50-degree field of view, posterior pole view.
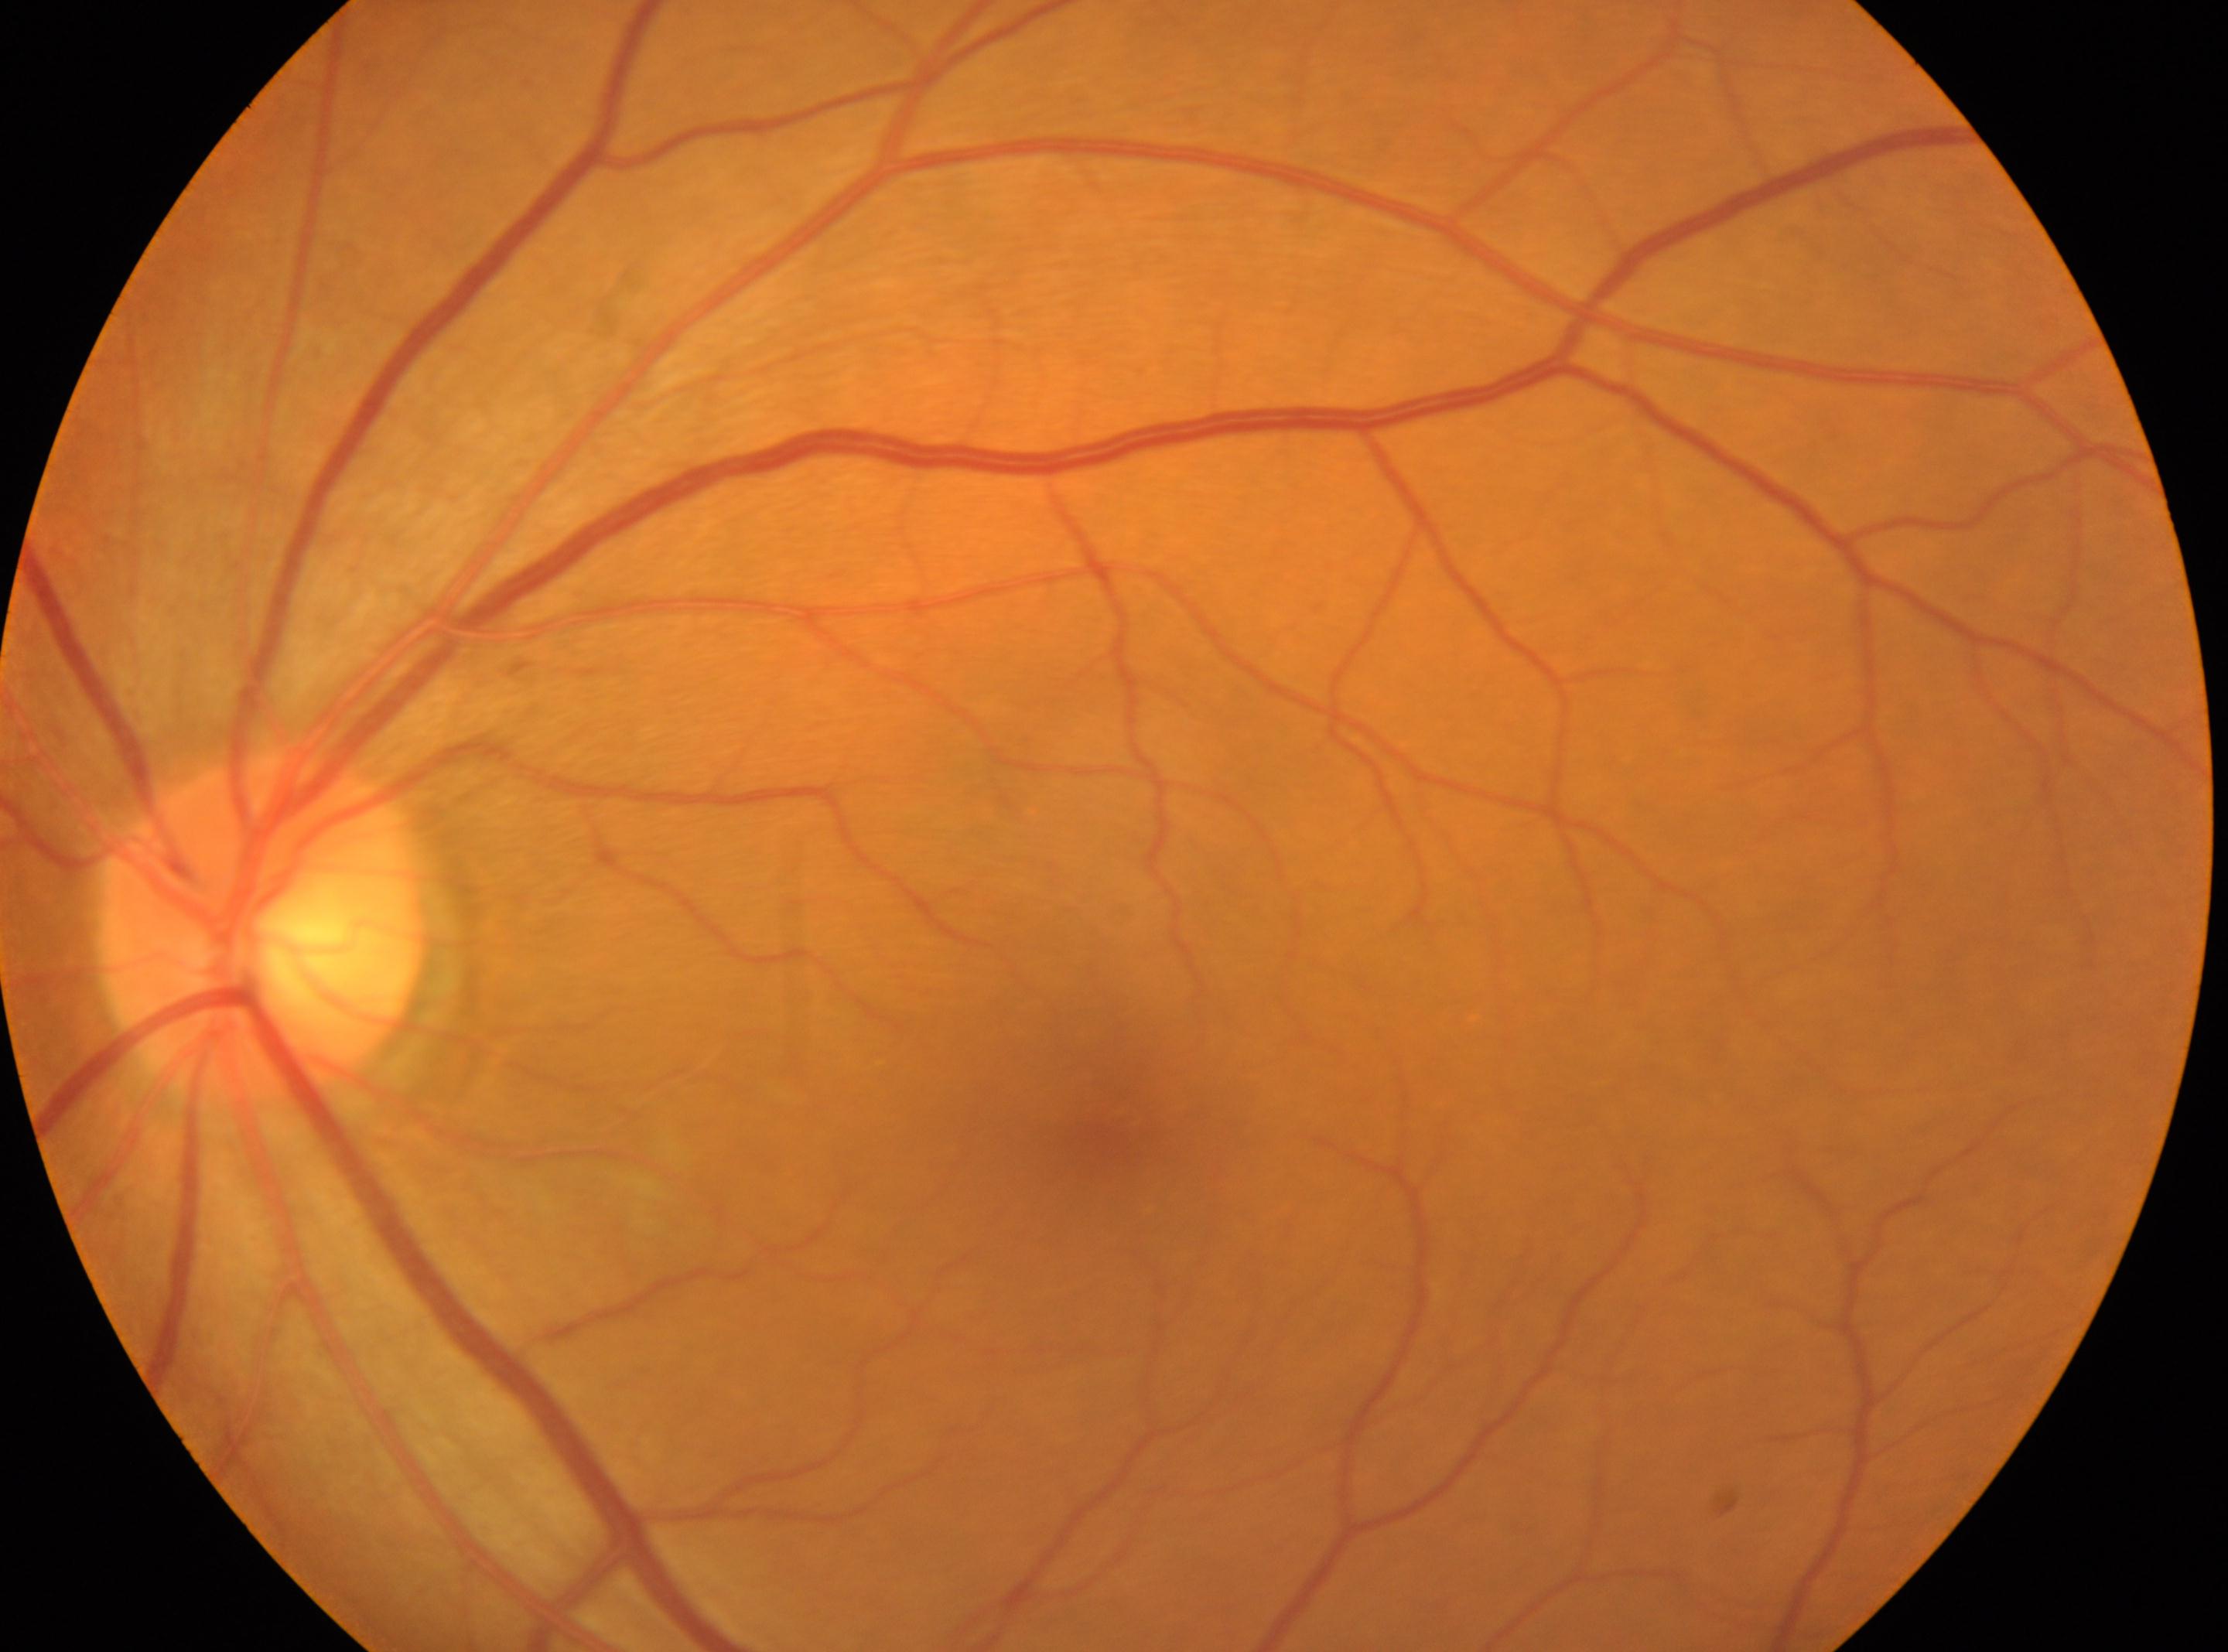
DR impression = No DR findings; laterality = the left eye; DR stage = 0; optic disk = 263px, 927px; fovea = 1122px, 1115px.